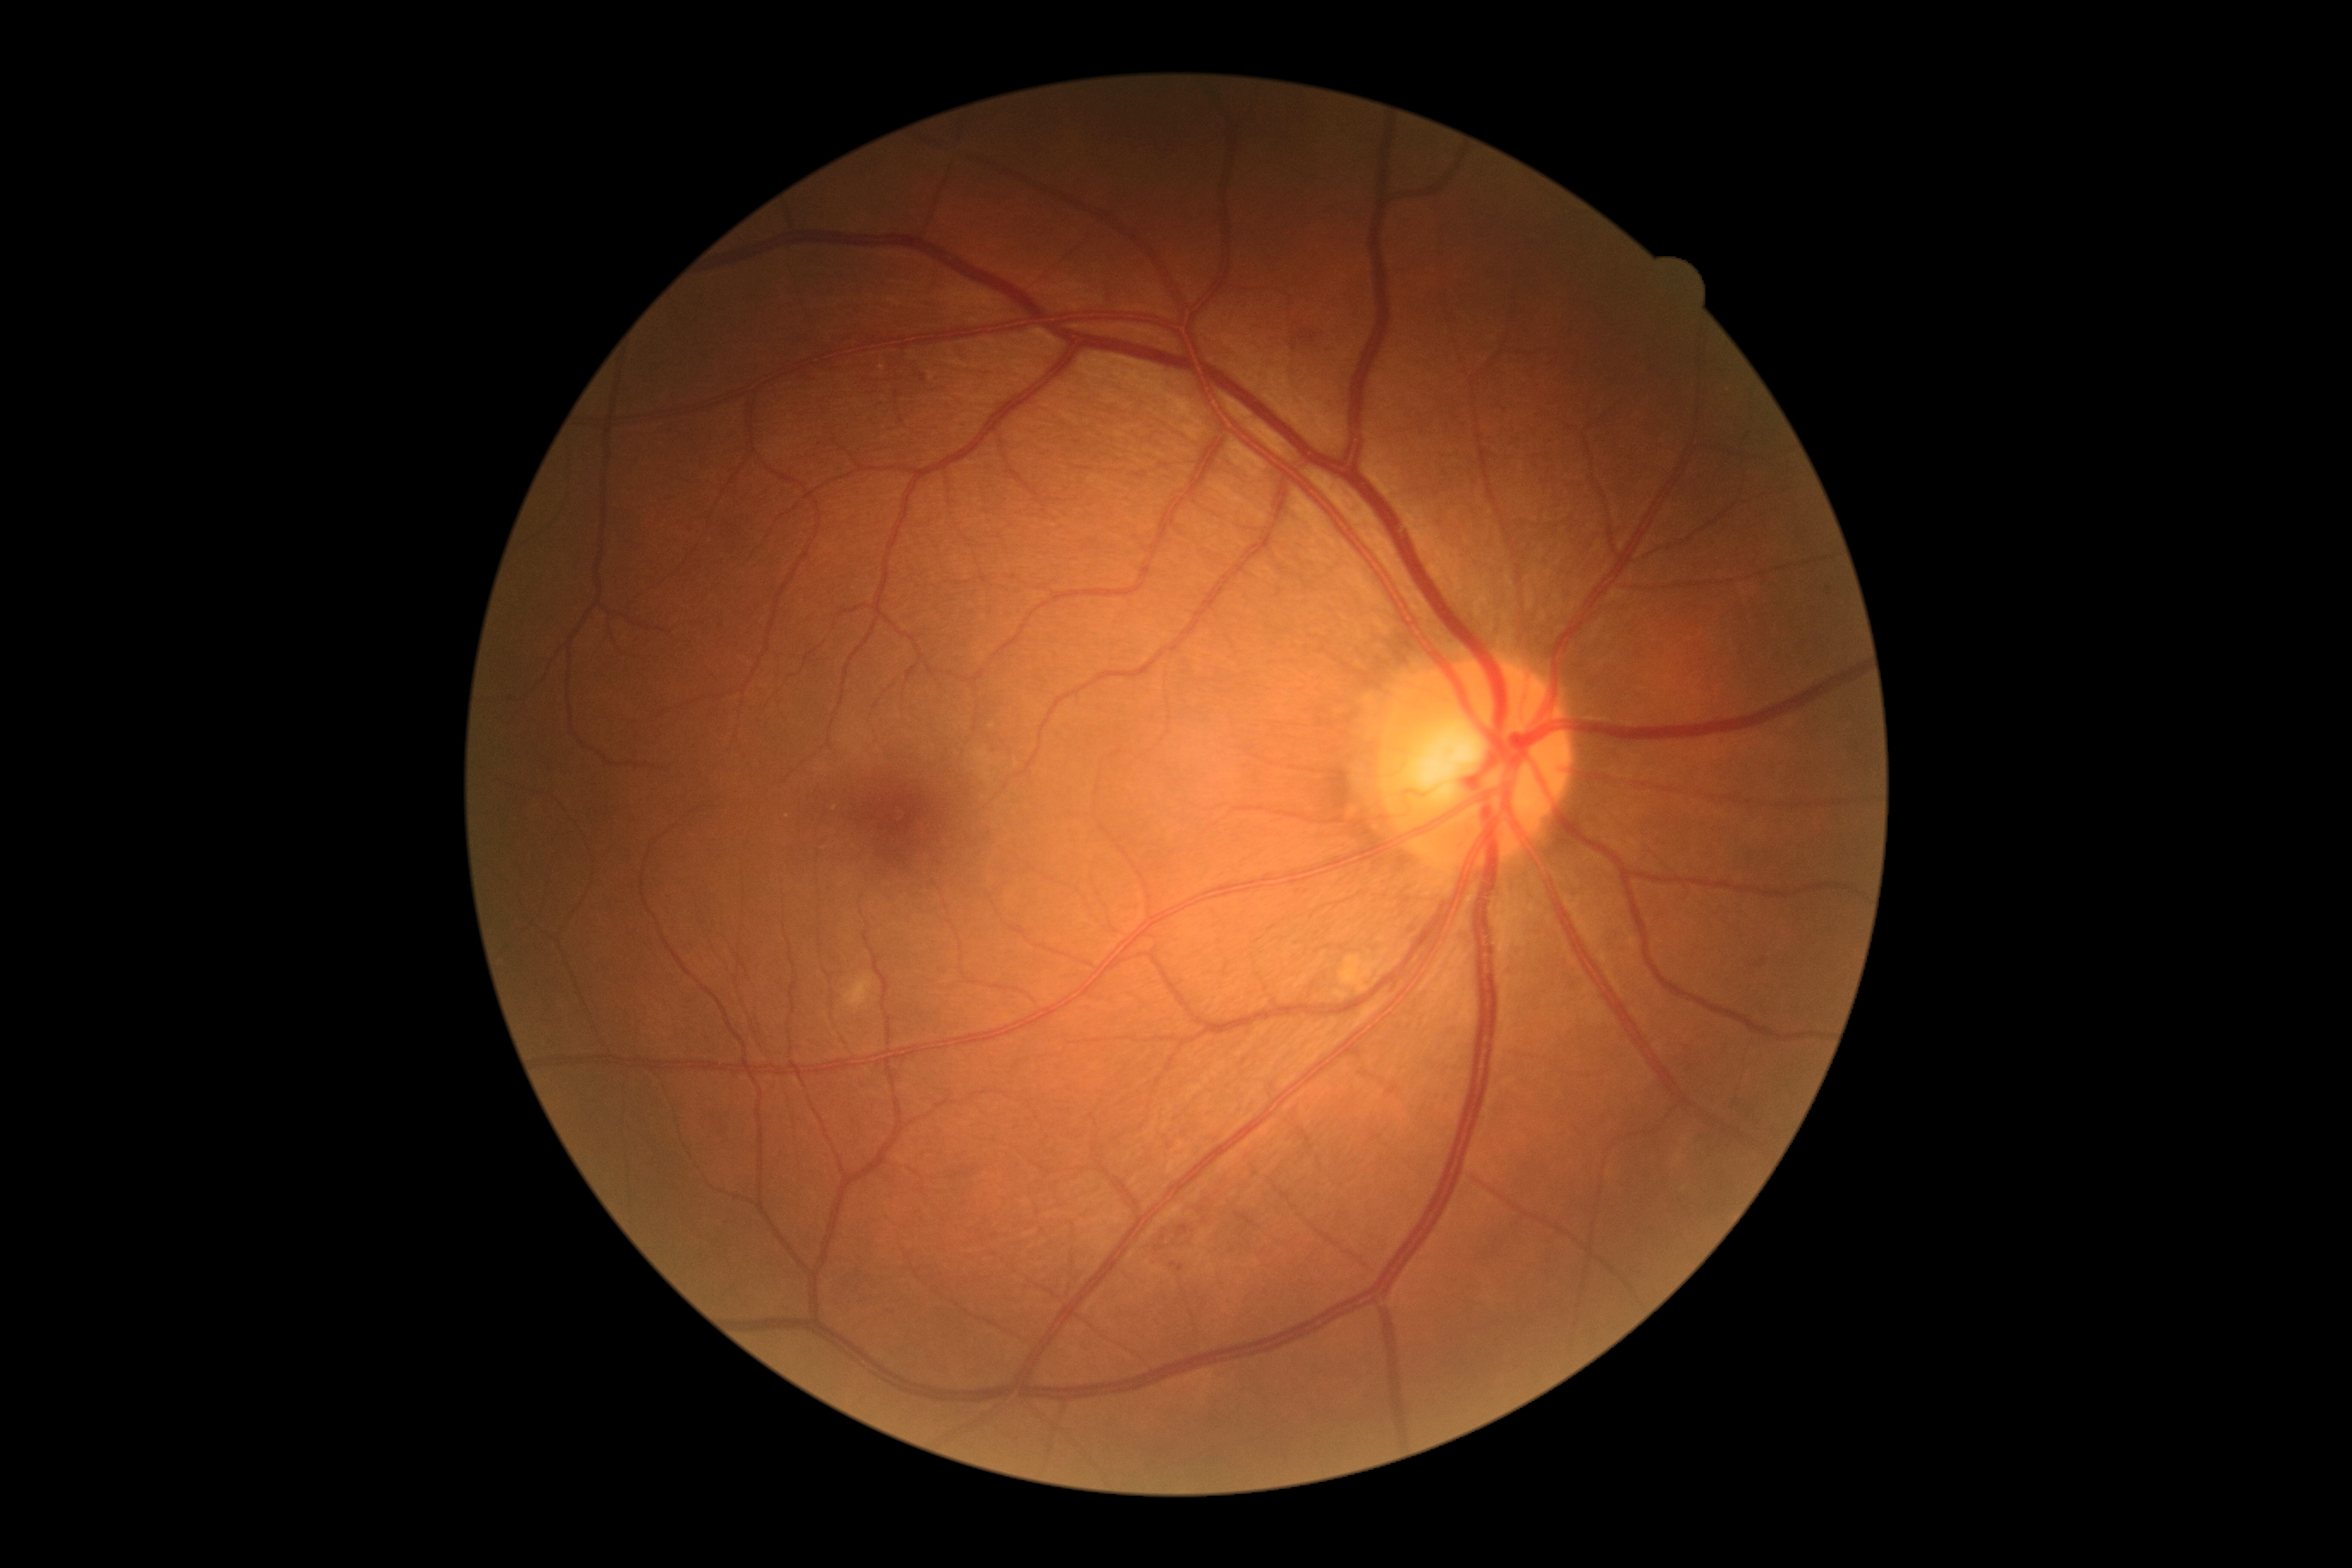 {
  "dr_grade": "moderate non-proliferative diabetic retinopathy (grade 2) — more than just microaneurysms but less than severe NPDR",
  "dr_category": "non-proliferative diabetic retinopathy"
}